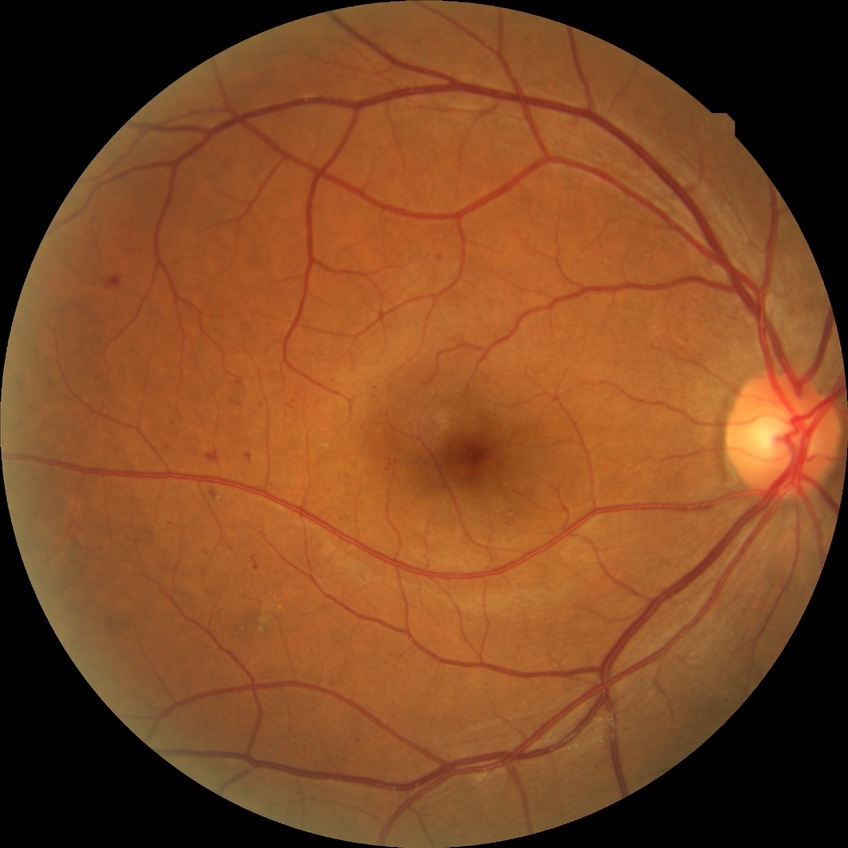 Diabetic retinopathy (DR) is SDR (simple diabetic retinopathy).